Color fundus image · 2212 x 1659 pixels
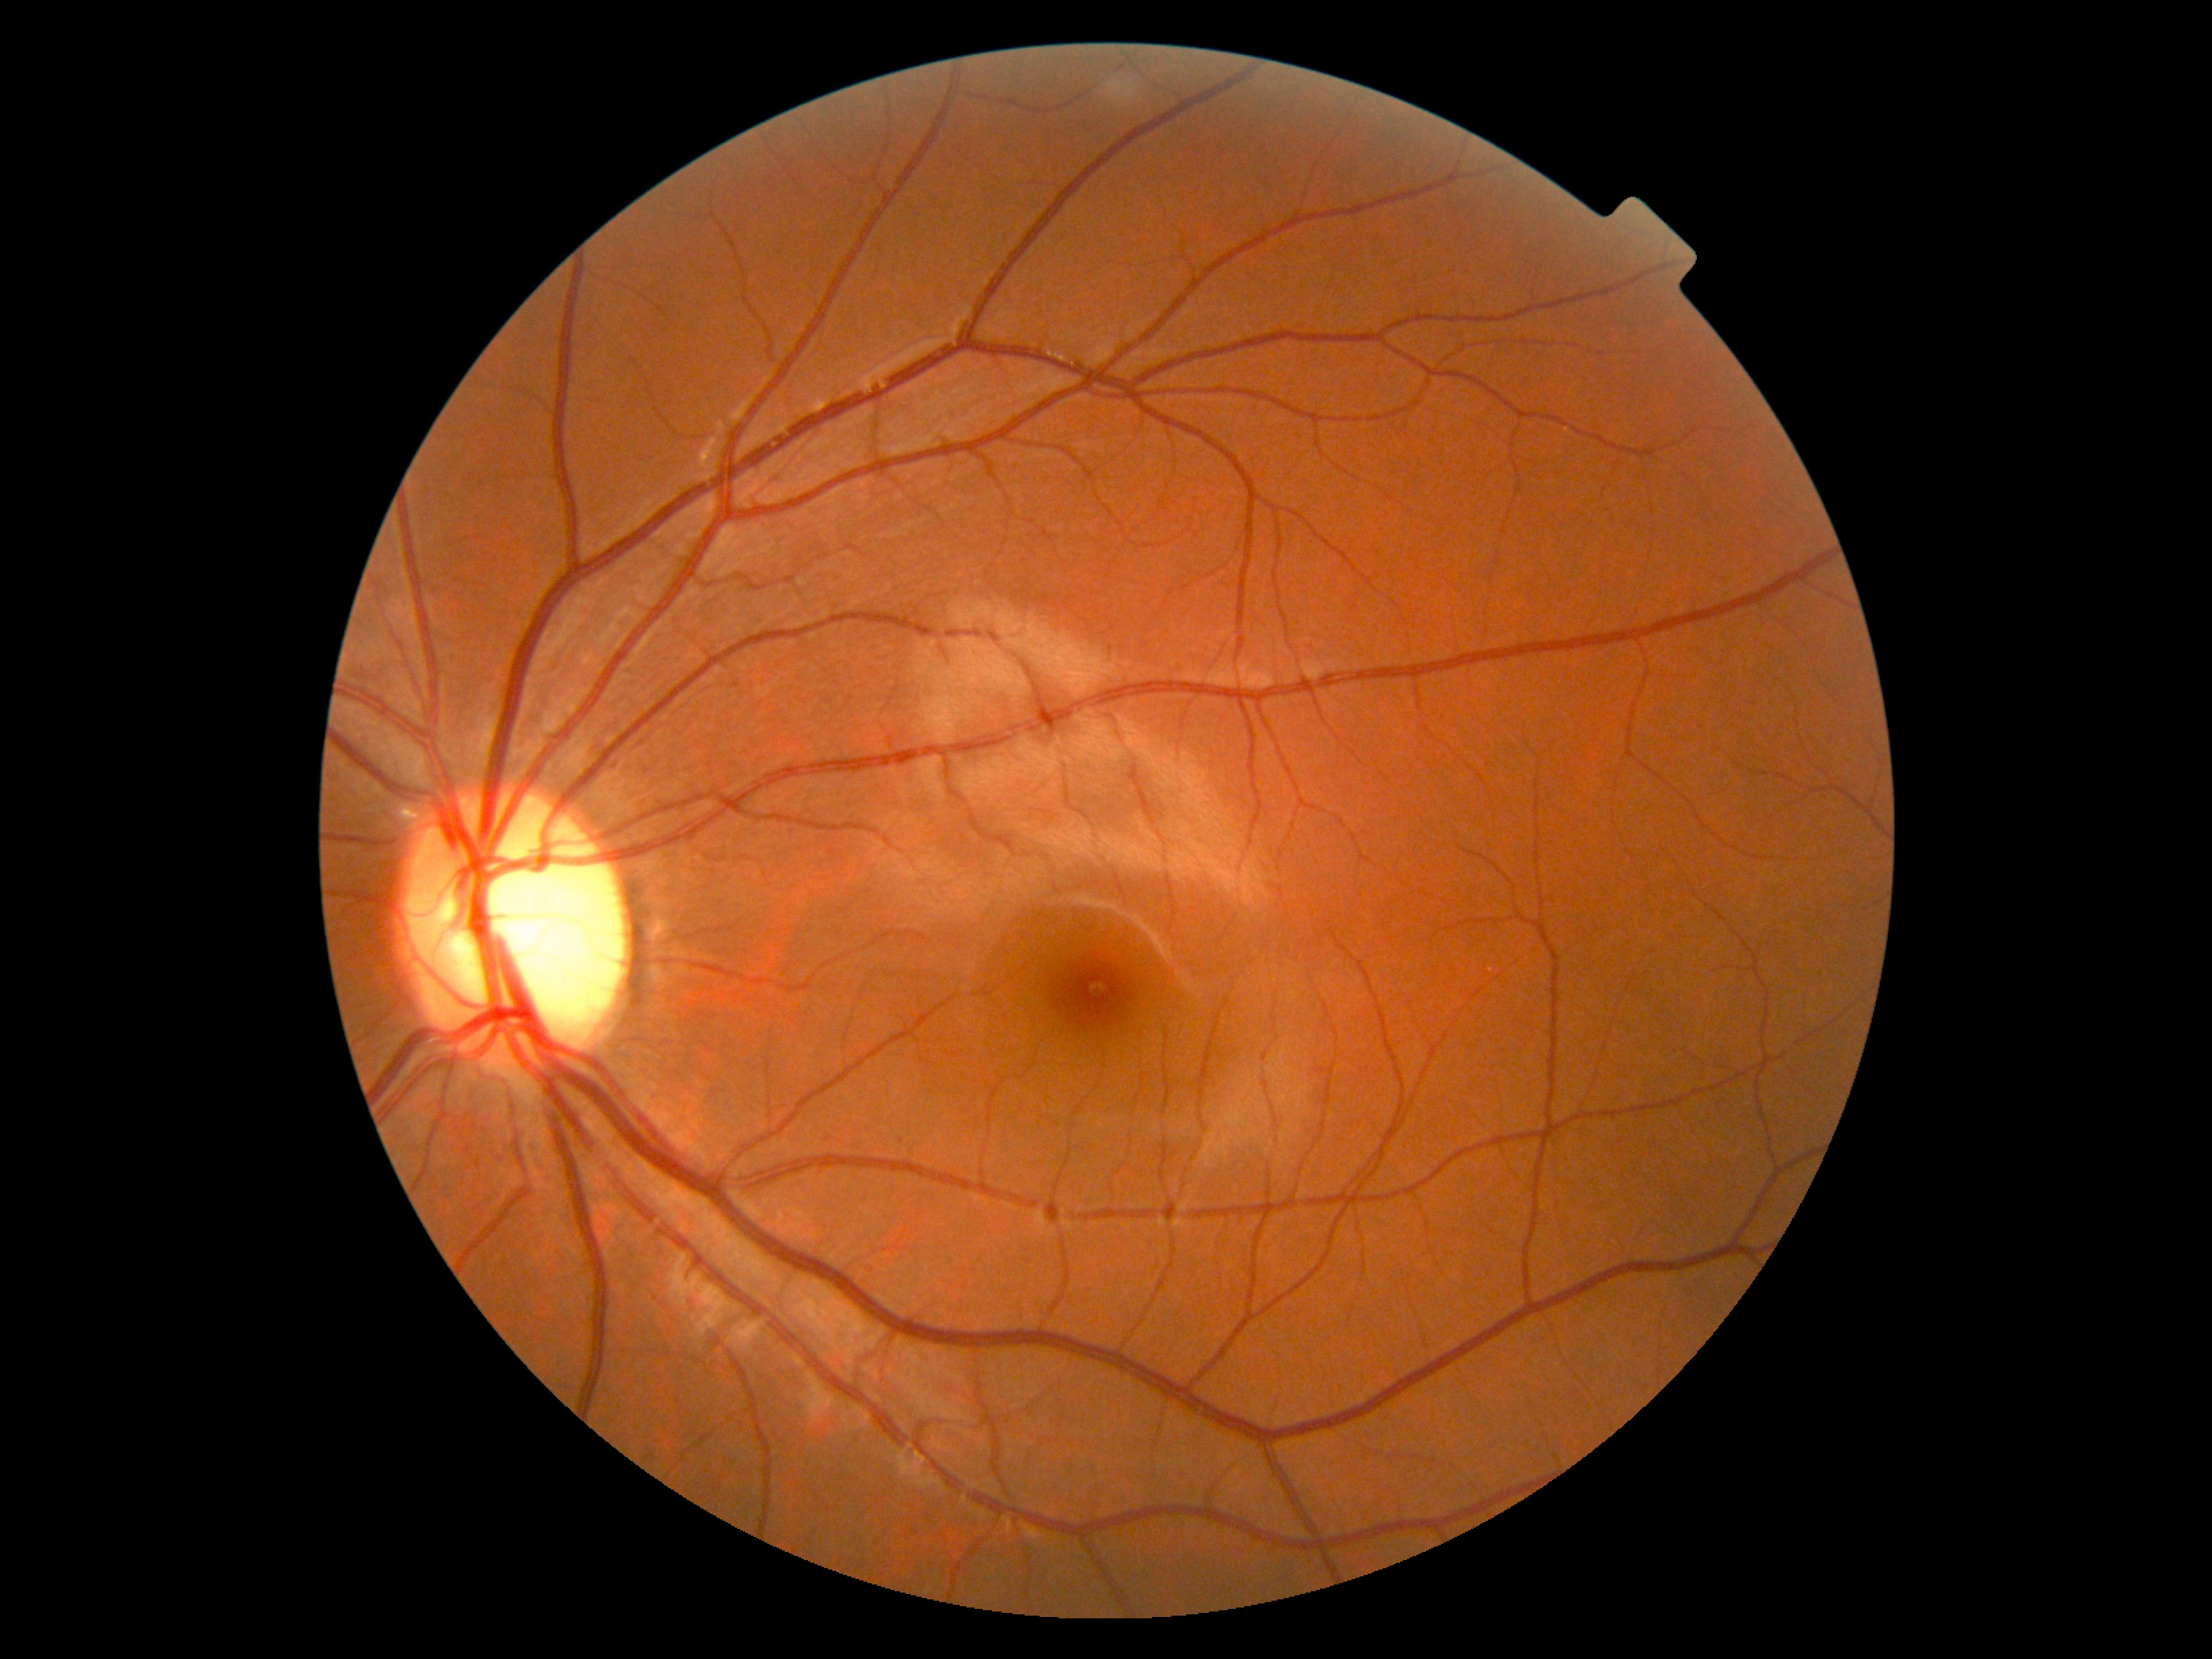 Retinopathy grade: 0 (no apparent retinopathy). No apparent diabetic retinopathy.